Image size 1440x1080. Wide-field fundus photograph of an infant: 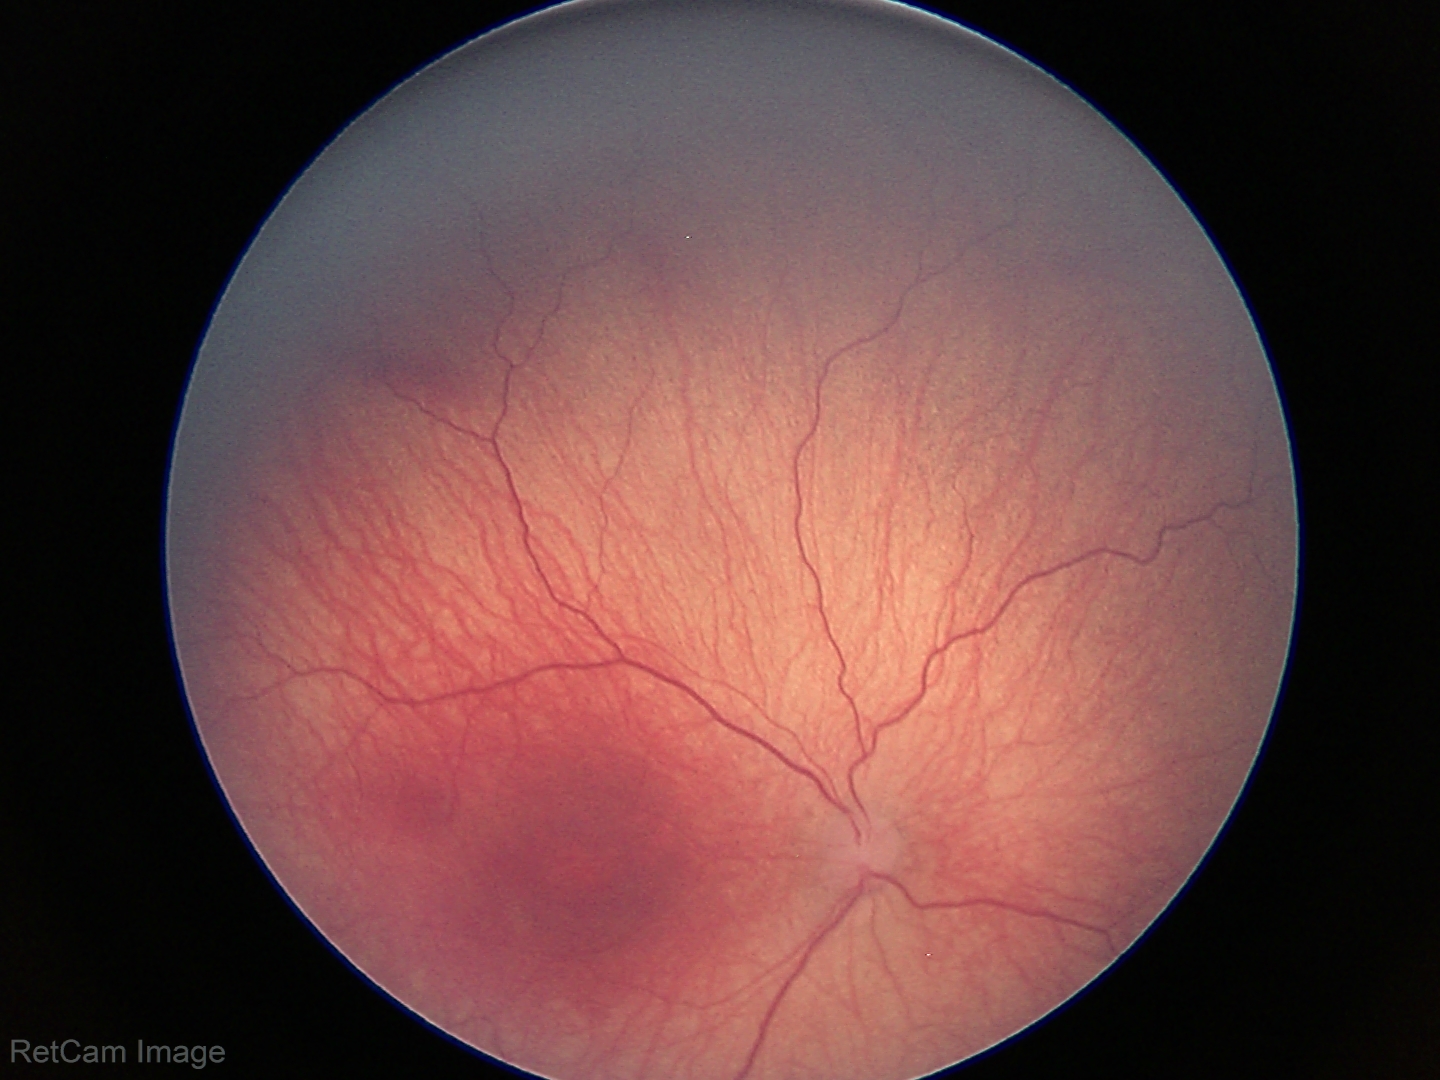

Screening series with ROP stage 1.